45-degree field of view · retinal fundus photograph · image size 1932x1932
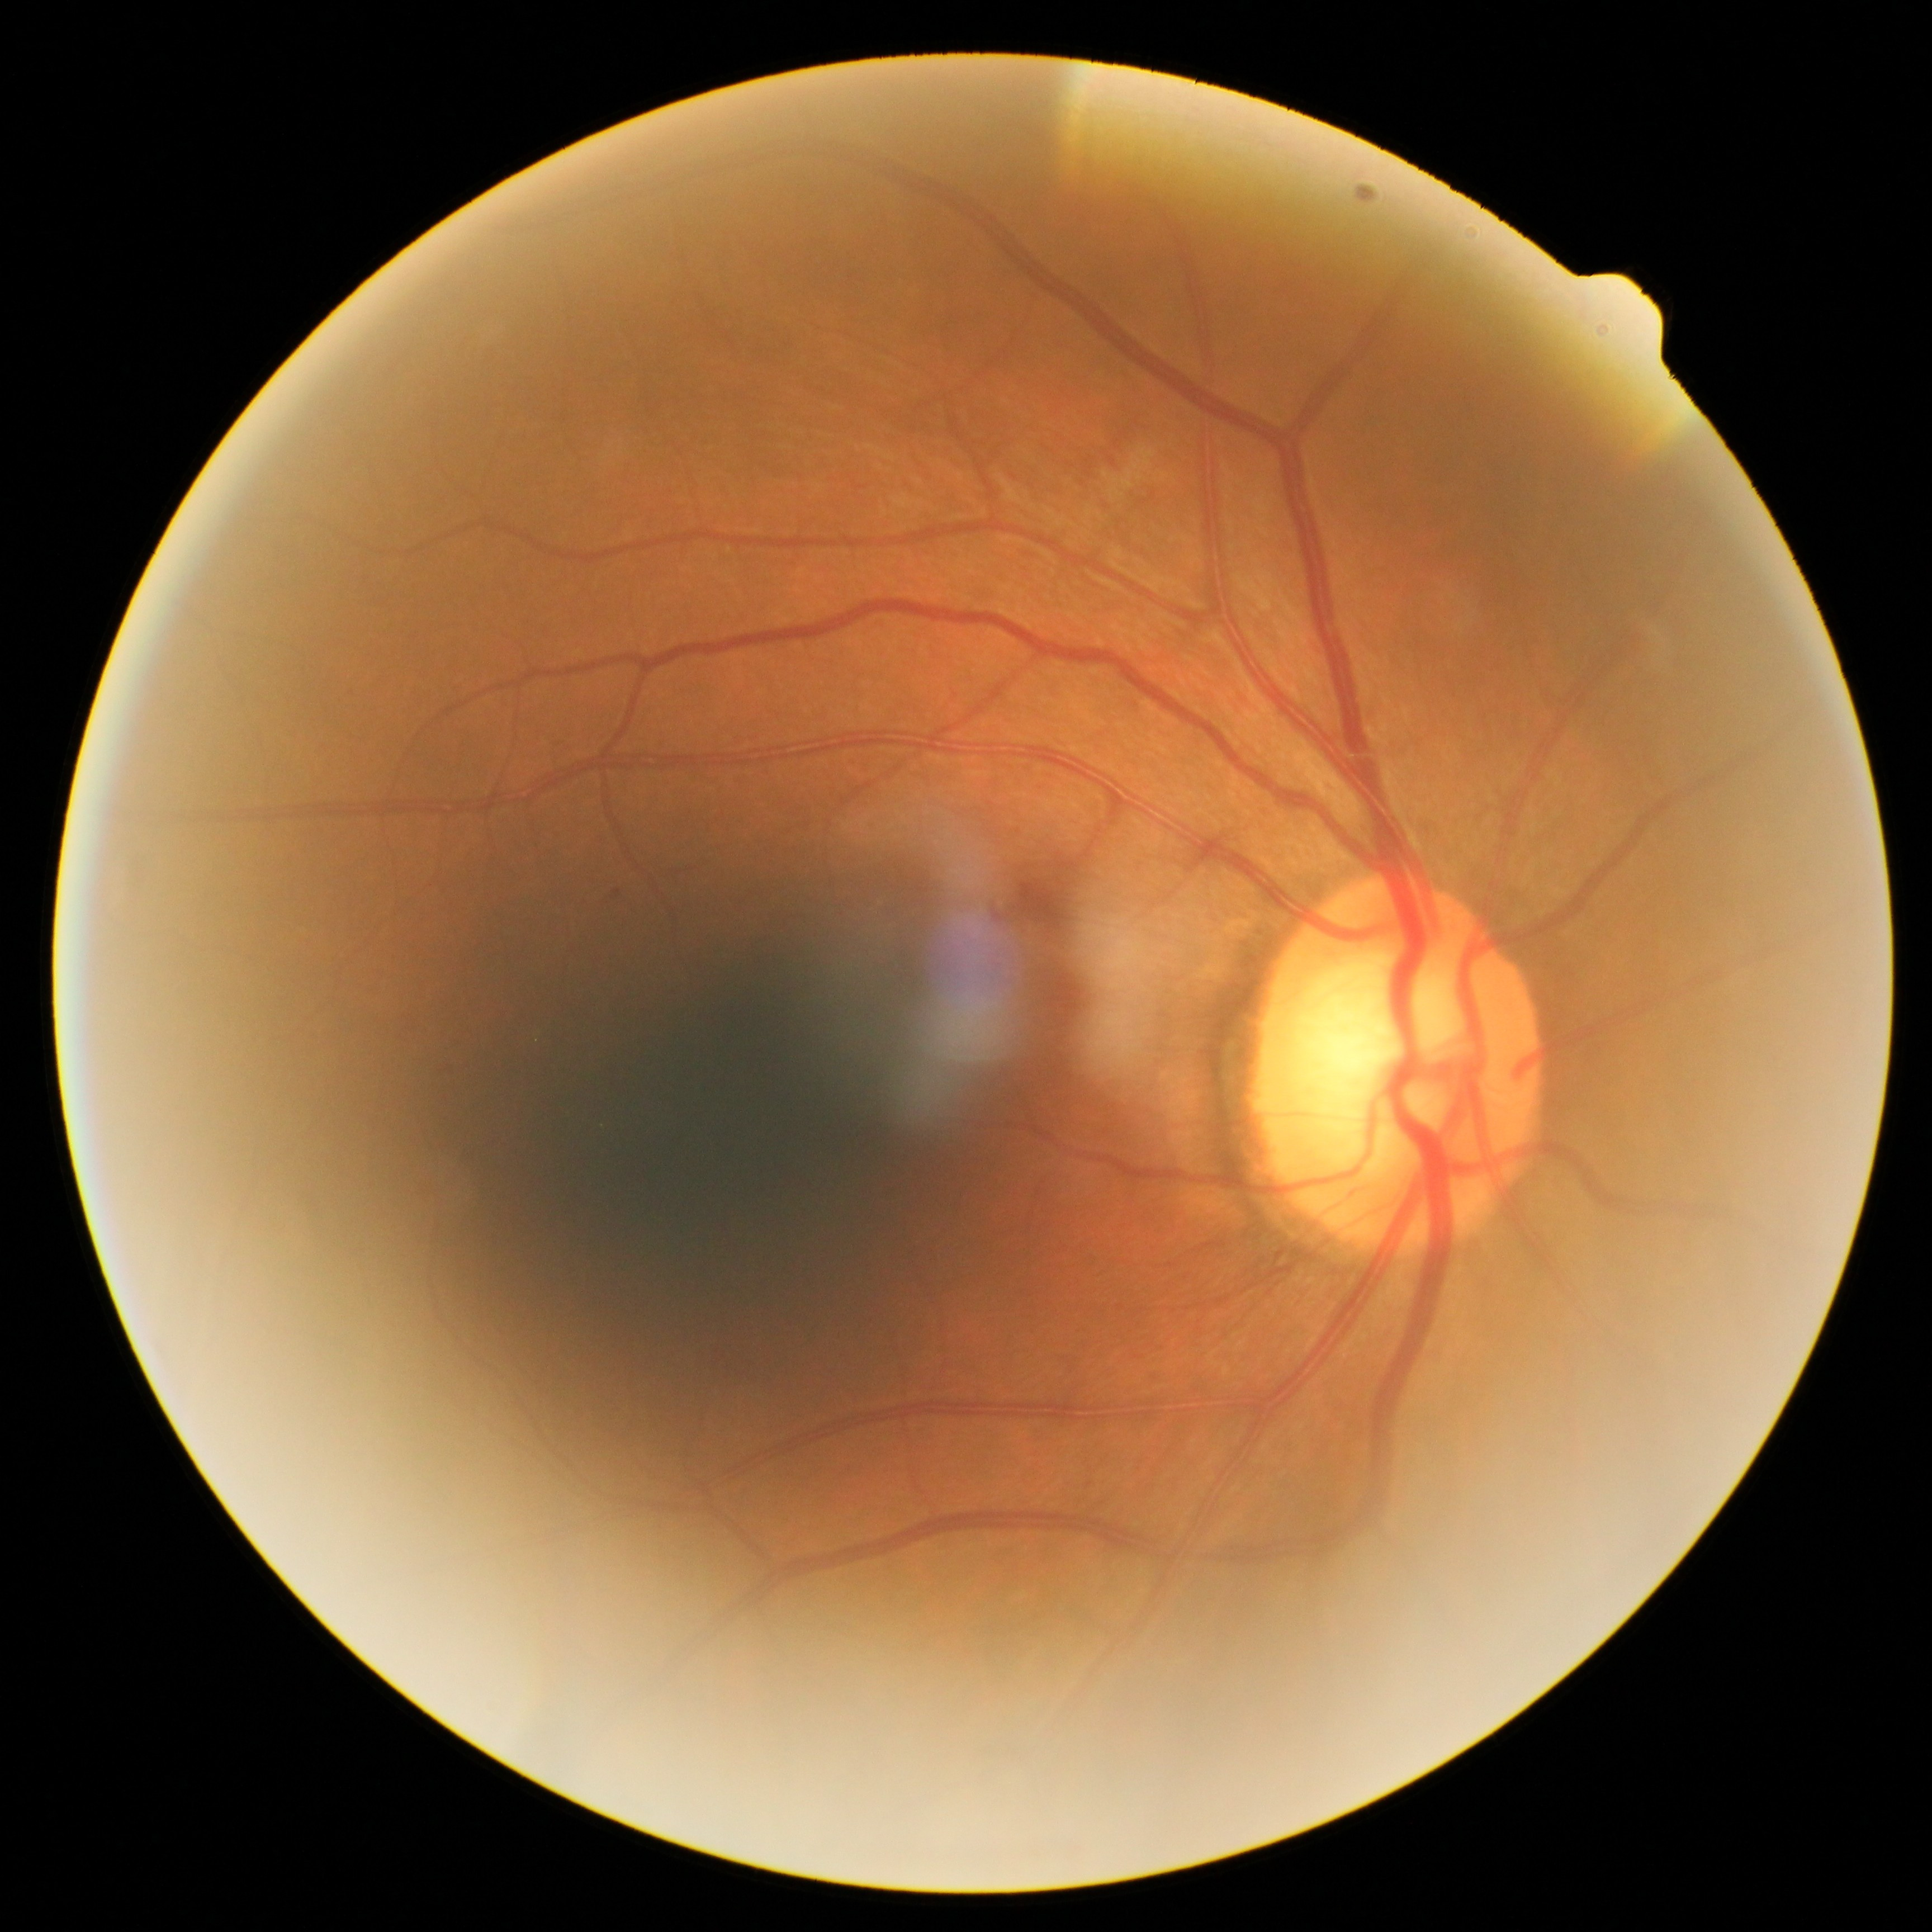

Diabetic retinopathy severity: 2/4.